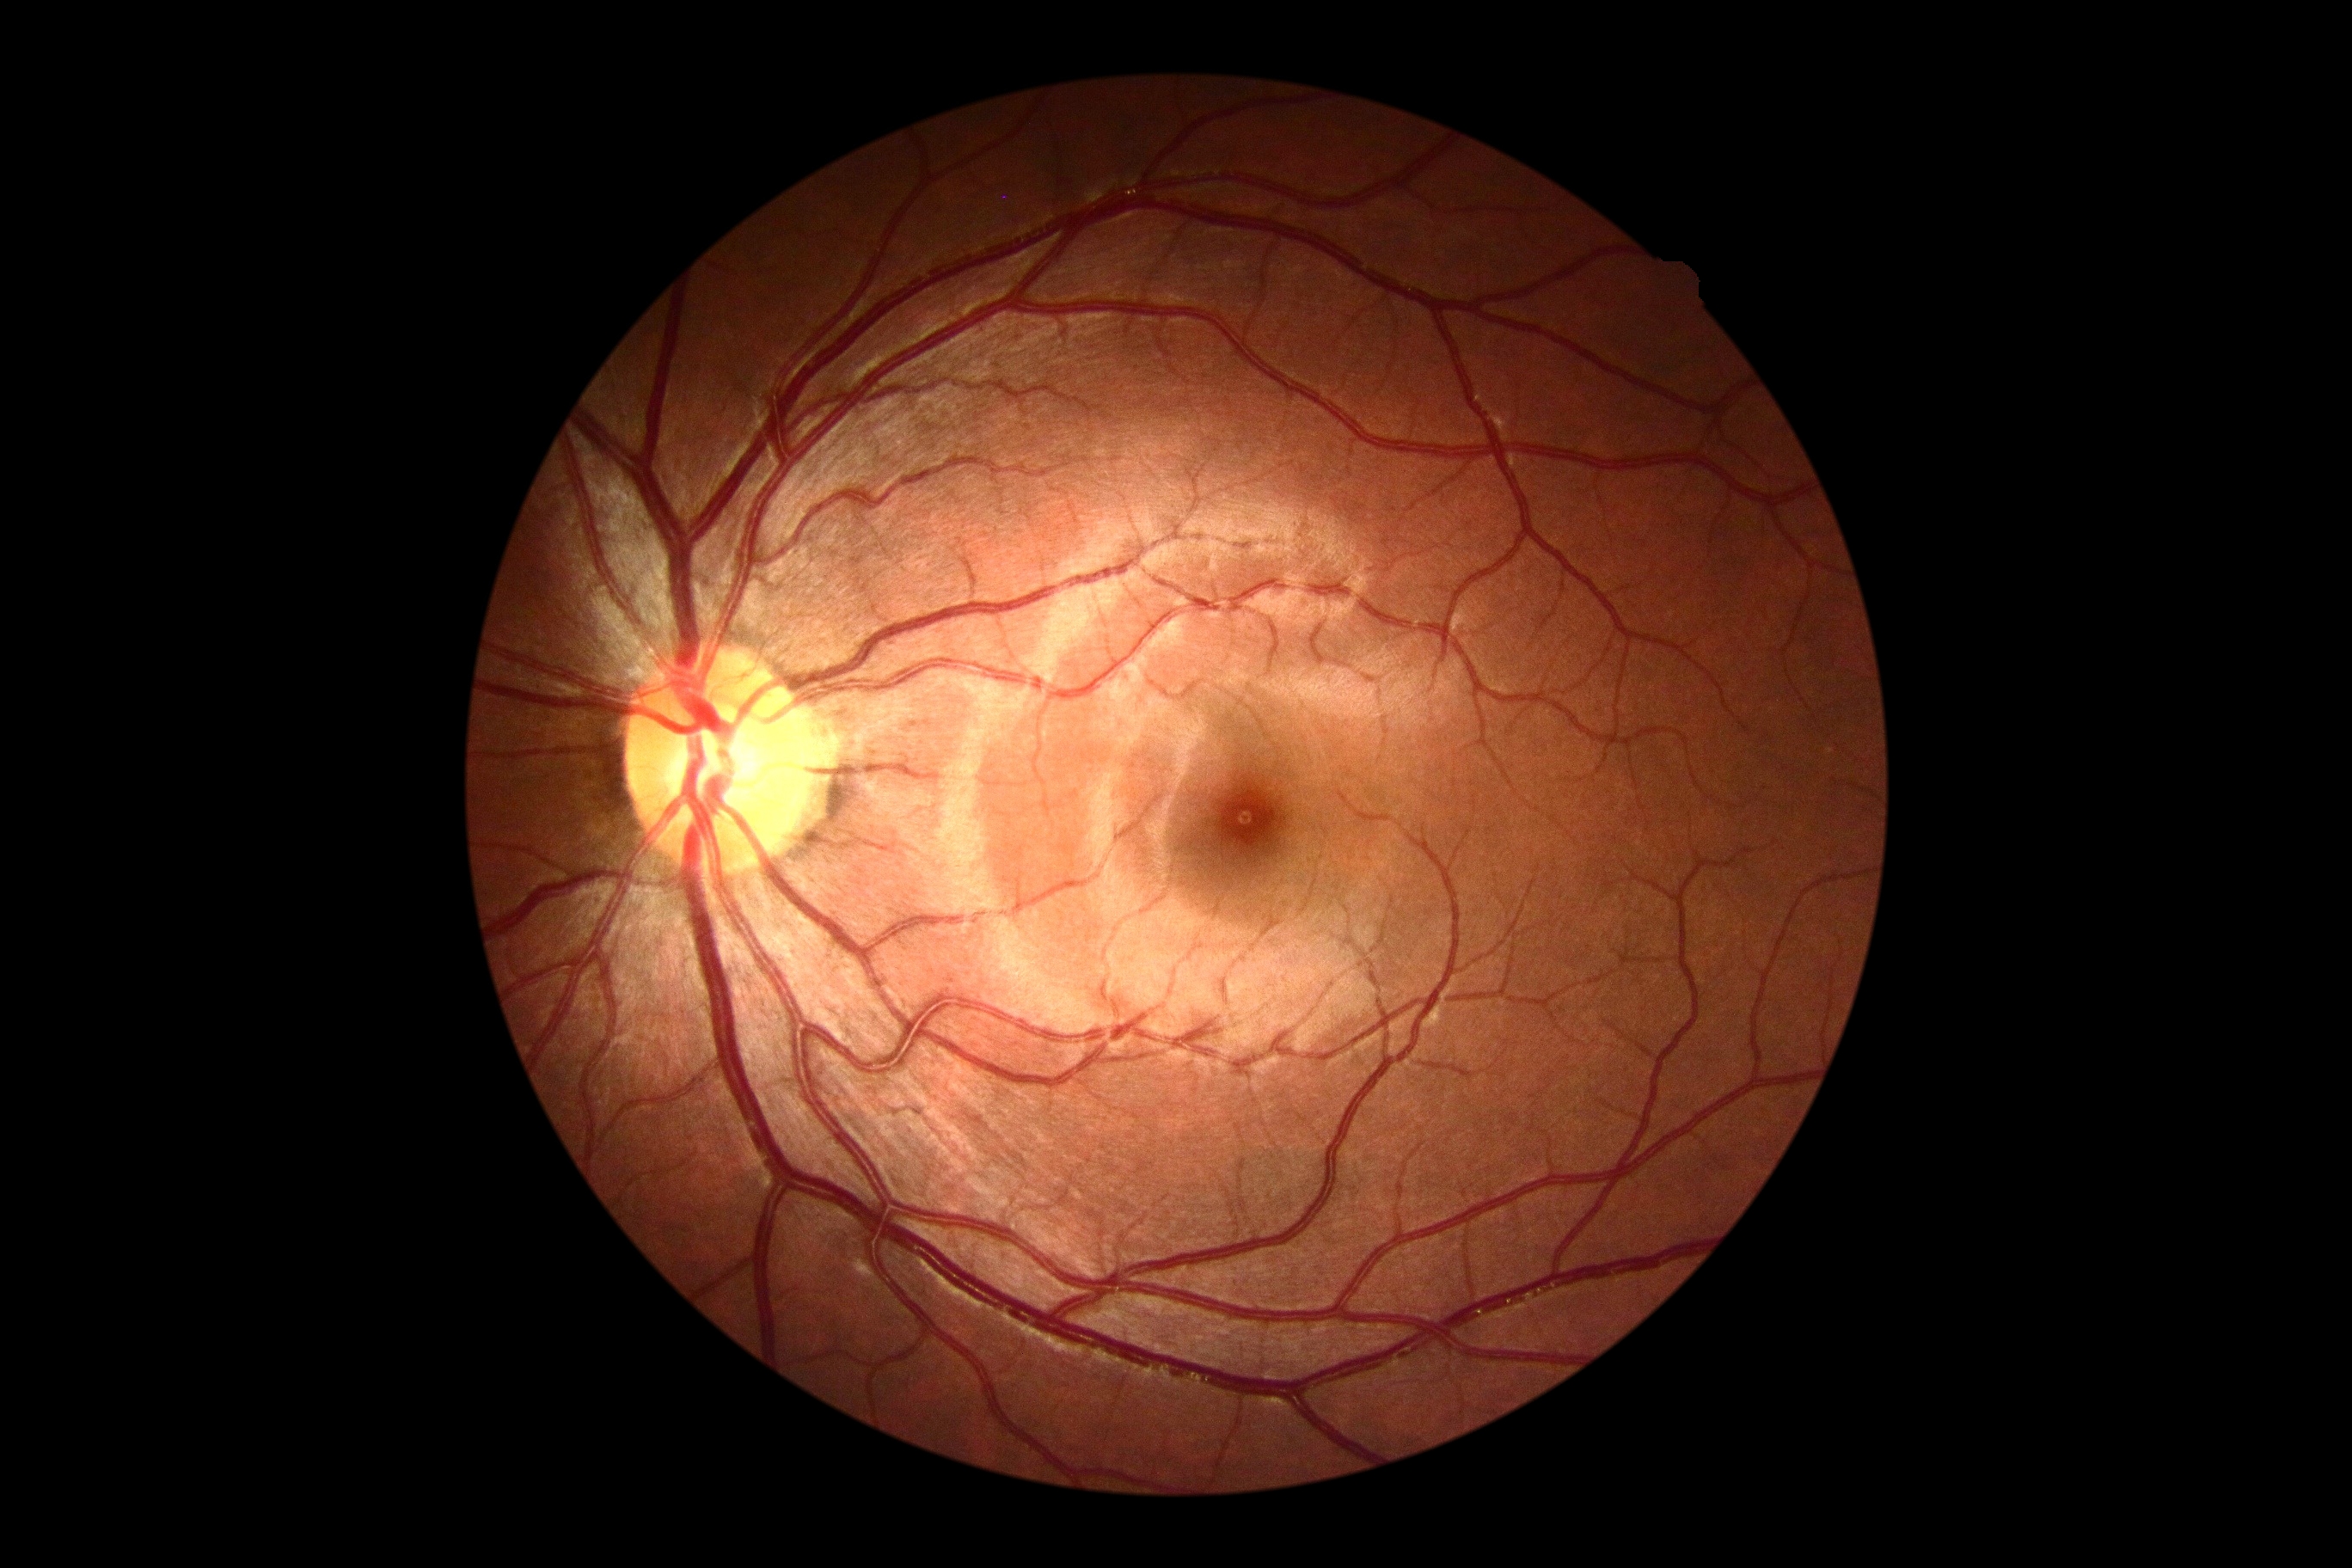 diabetic retinopathy severity: grade 0 (no apparent retinopathy) — no visible signs of diabetic retinopathy.